Diabetic retinopathy graded by the modified Davis classification. CFP. 848 x 848 pixels:
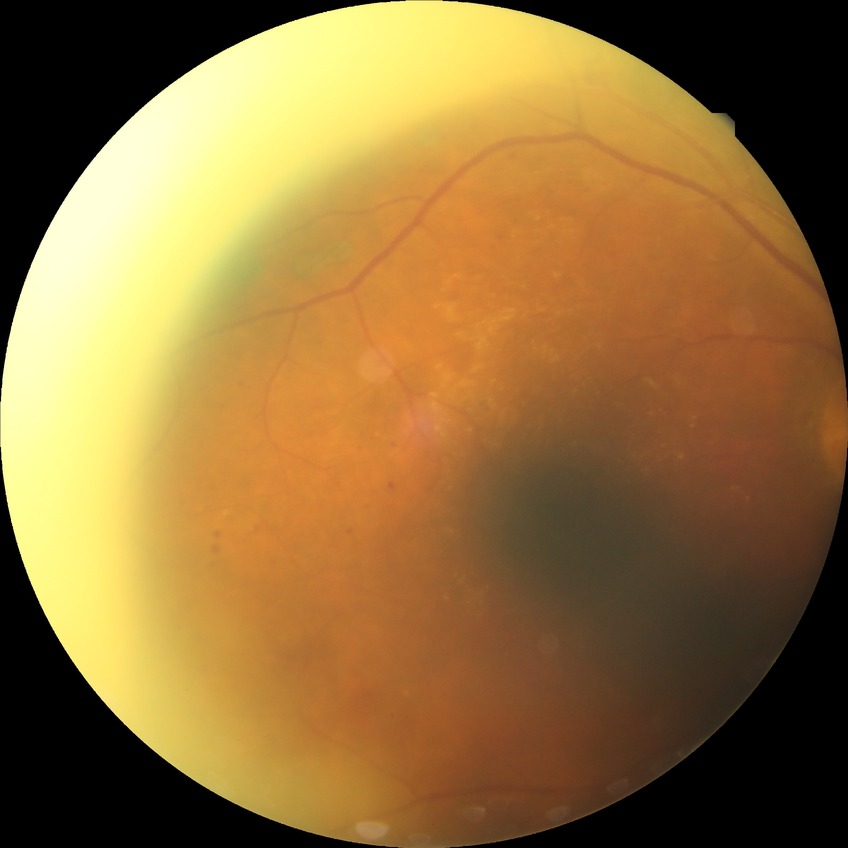

diabetic retinopathy stage = proliferative diabetic retinopathy.